45-degree field of view. CFP. 2352 x 1568 pixels:
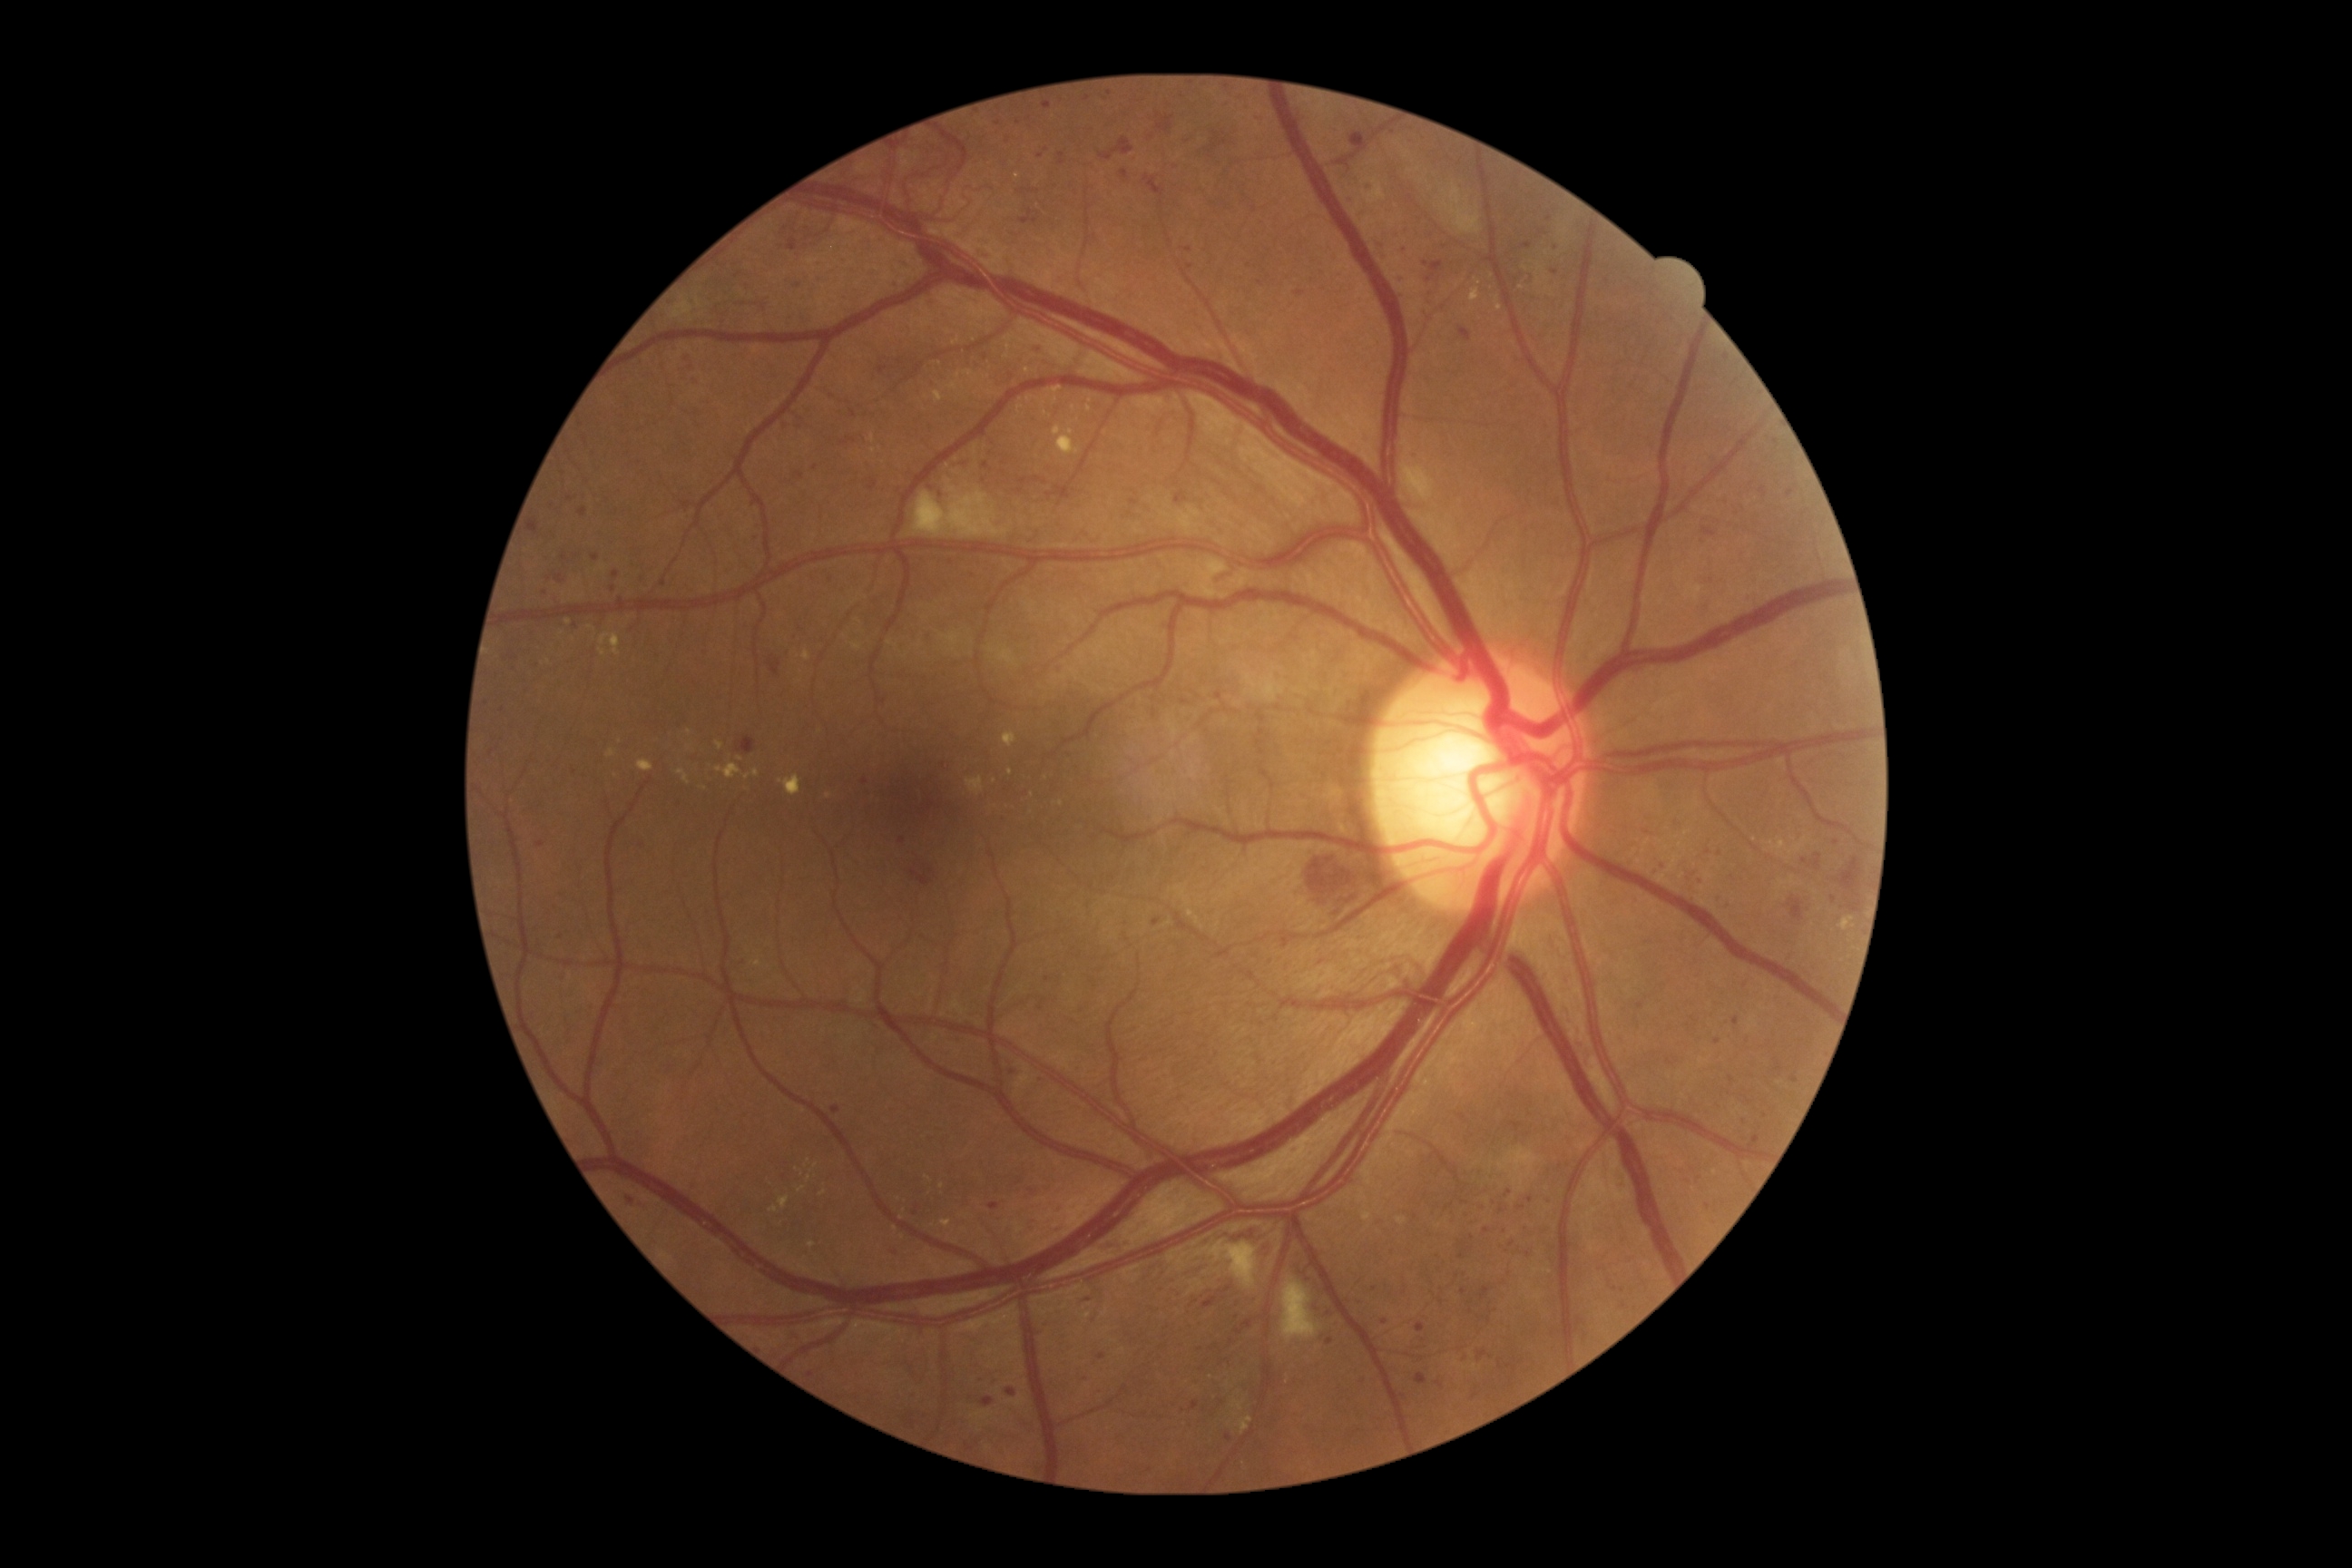

<lesions partial="true">
  <dr_grade>3</dr_grade>
  <ex partial="true"><box>965,371,974,377</box> | <box>1026,397,1034,402</box> | <box>752,769,760,778</box> | <box>716,765,741,779</box> | <box>948,382,959,391</box> | <box>803,651,810,662</box> | <box>779,1197,790,1208</box> | <box>678,770,691,785</box></ex>
  <ex_small_centers>pt(592, 629) | pt(1044, 404) | pt(1020, 409) | pt(549, 661) | pt(829, 796) | pt(895, 1229) | pt(1056, 401) | pt(991, 393) | pt(1498, 300)</ex_small_centers>
  <ma partial="true"><box>1396,228,1409,239</box> | <box>636,839,642,848</box> | <box>562,554,567,562</box> | <box>990,1202,1001,1211</box> | <box>1039,999,1046,1010</box> | <box>917,1188,925,1195</box> | <box>1097,1353,1106,1360</box> | <box>1761,487,1769,496</box> | <box>1057,1199,1064,1211</box> | <box>888,1242,901,1255</box></ma>
  <ma_small_centers>pt(1718, 1043) | pt(576, 627) | pt(1110, 94) | pt(1487, 1230) | pt(1508, 1194) | pt(987, 466) | pt(1442, 1302) | pt(614, 590) | pt(1189, 250)</ma_small_centers>
</lesions>